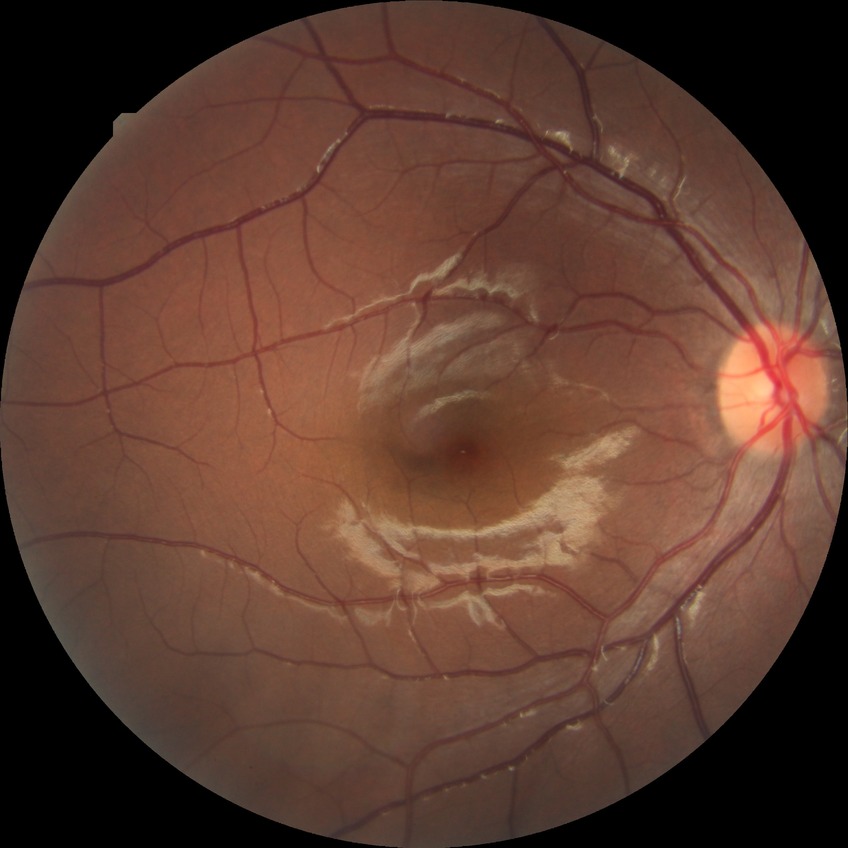

Davis grade is NDR.